2212 x 1659 pixels:
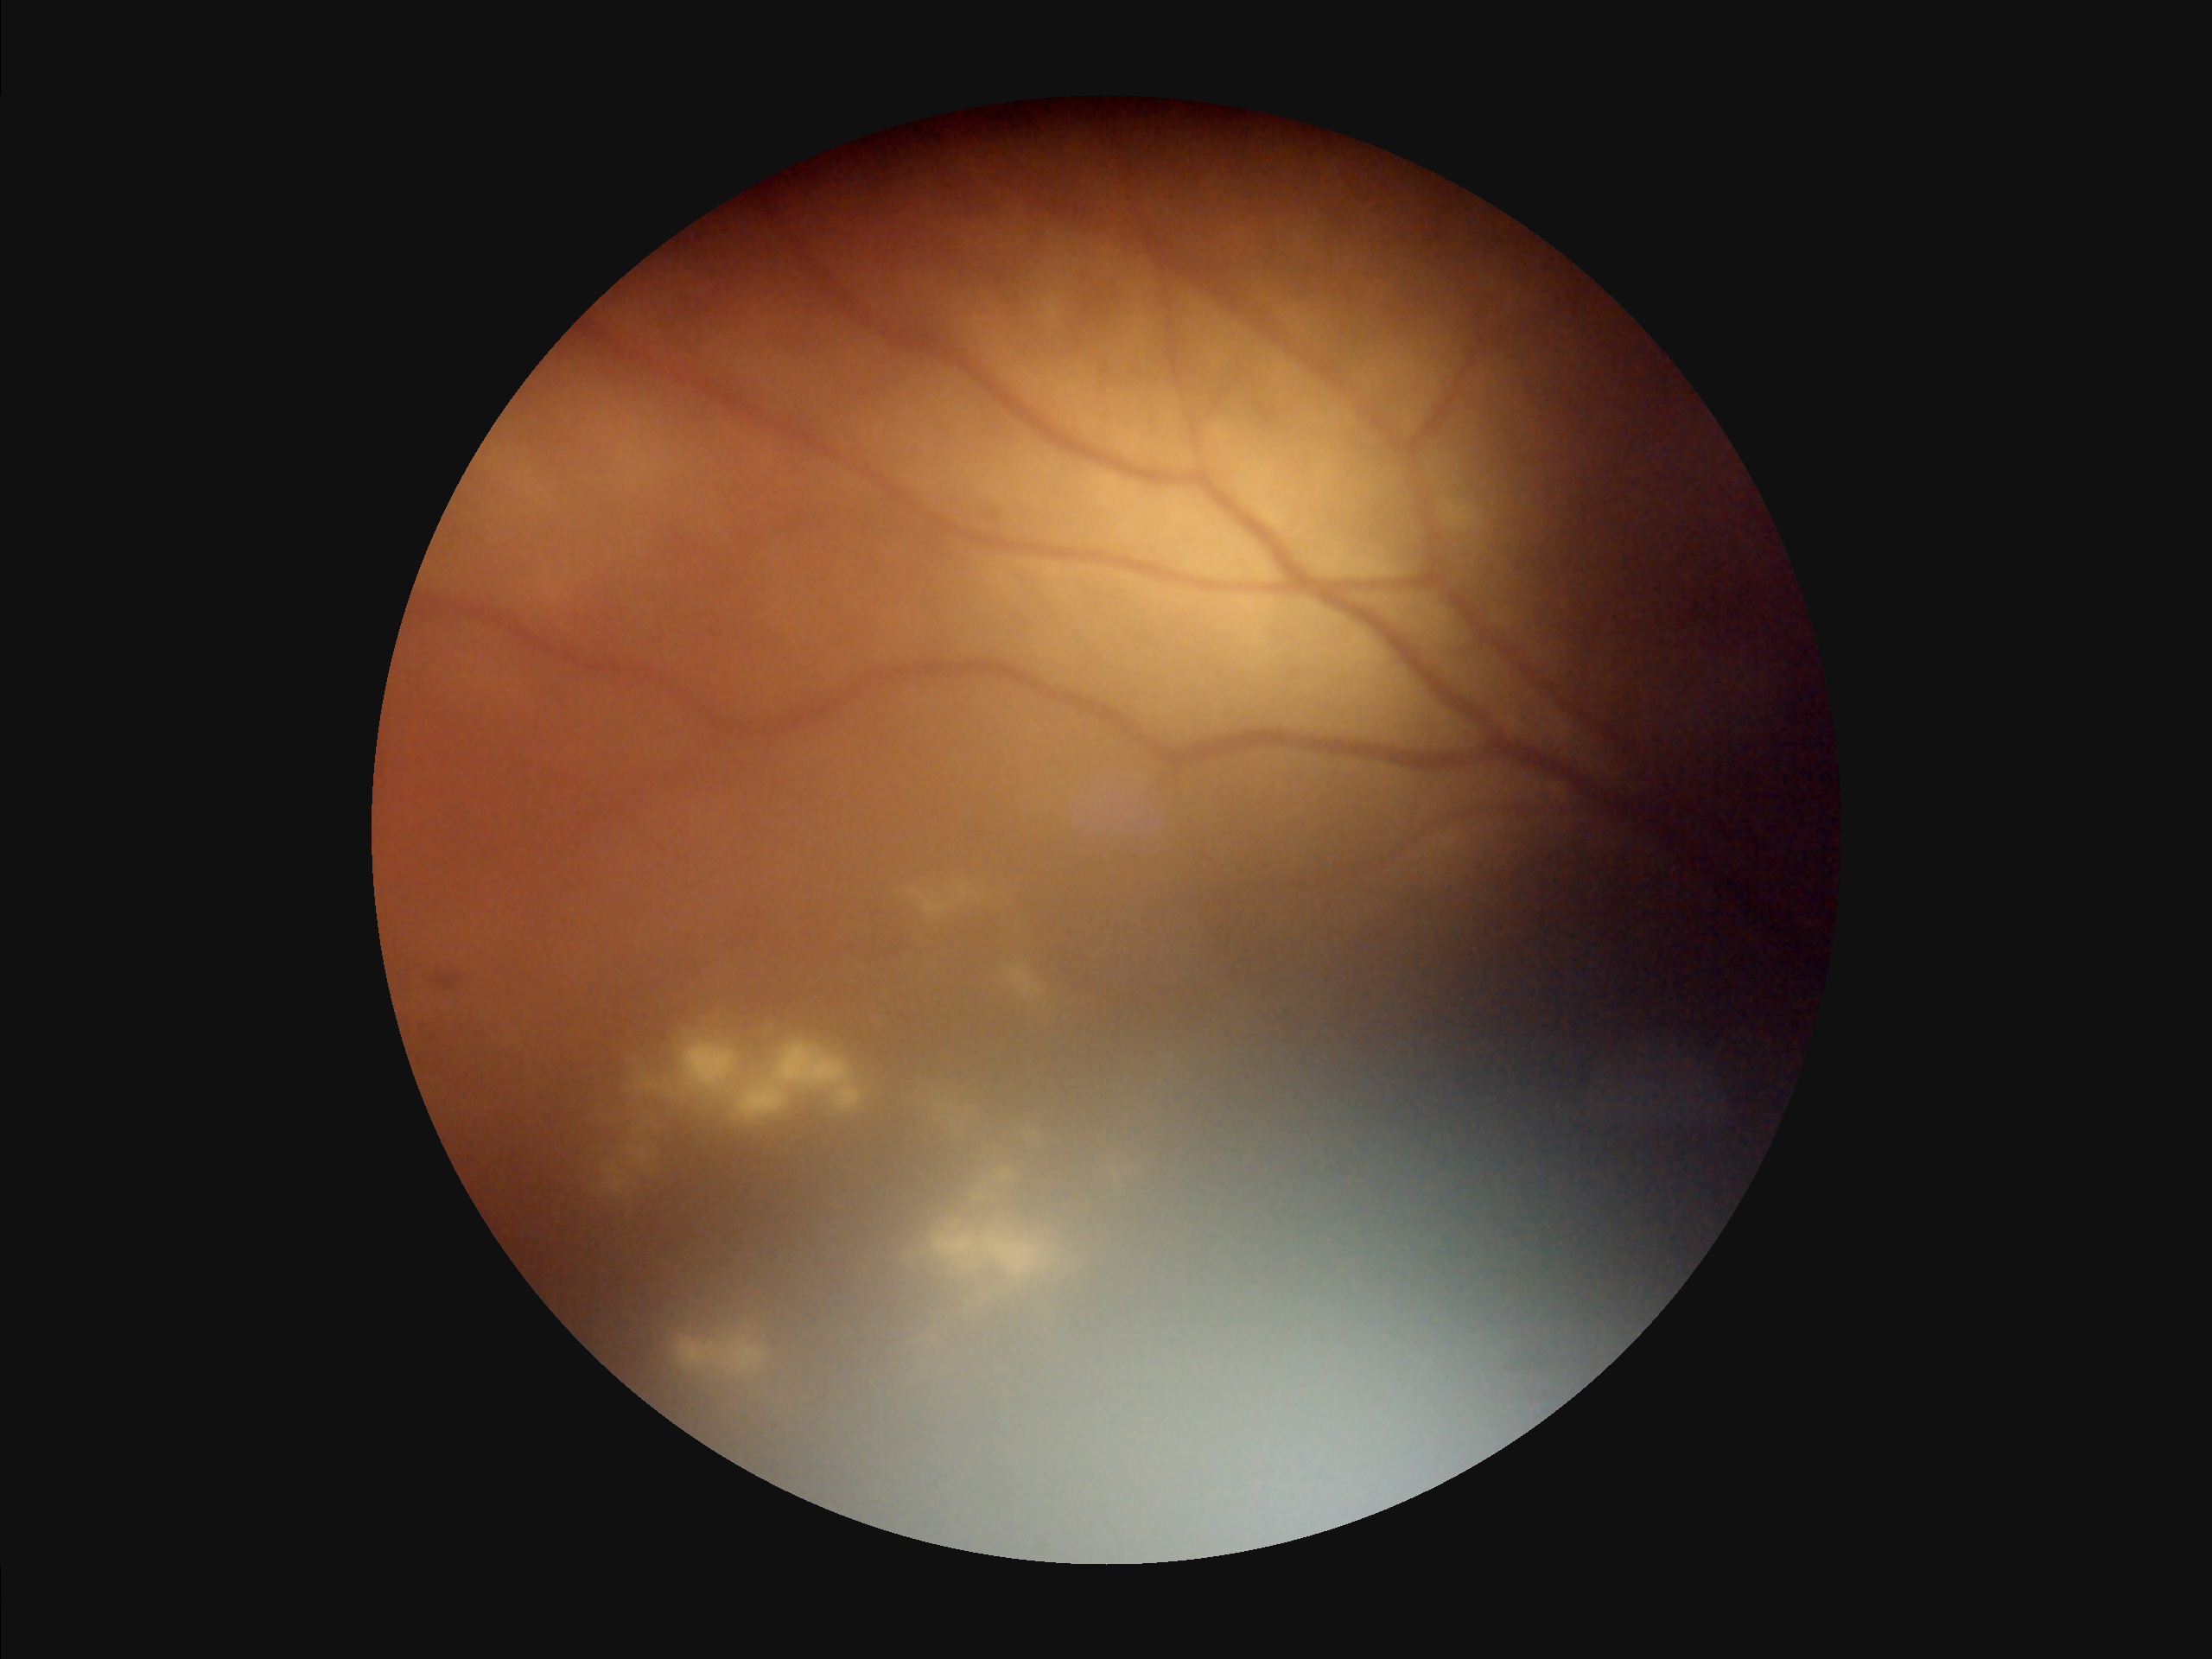 Contrast is low. Noticeable blur in the optic disc, vessels, or background. There is over- or under-exposure or a color cast. Overall quality is poor; the image is difficult to grade.